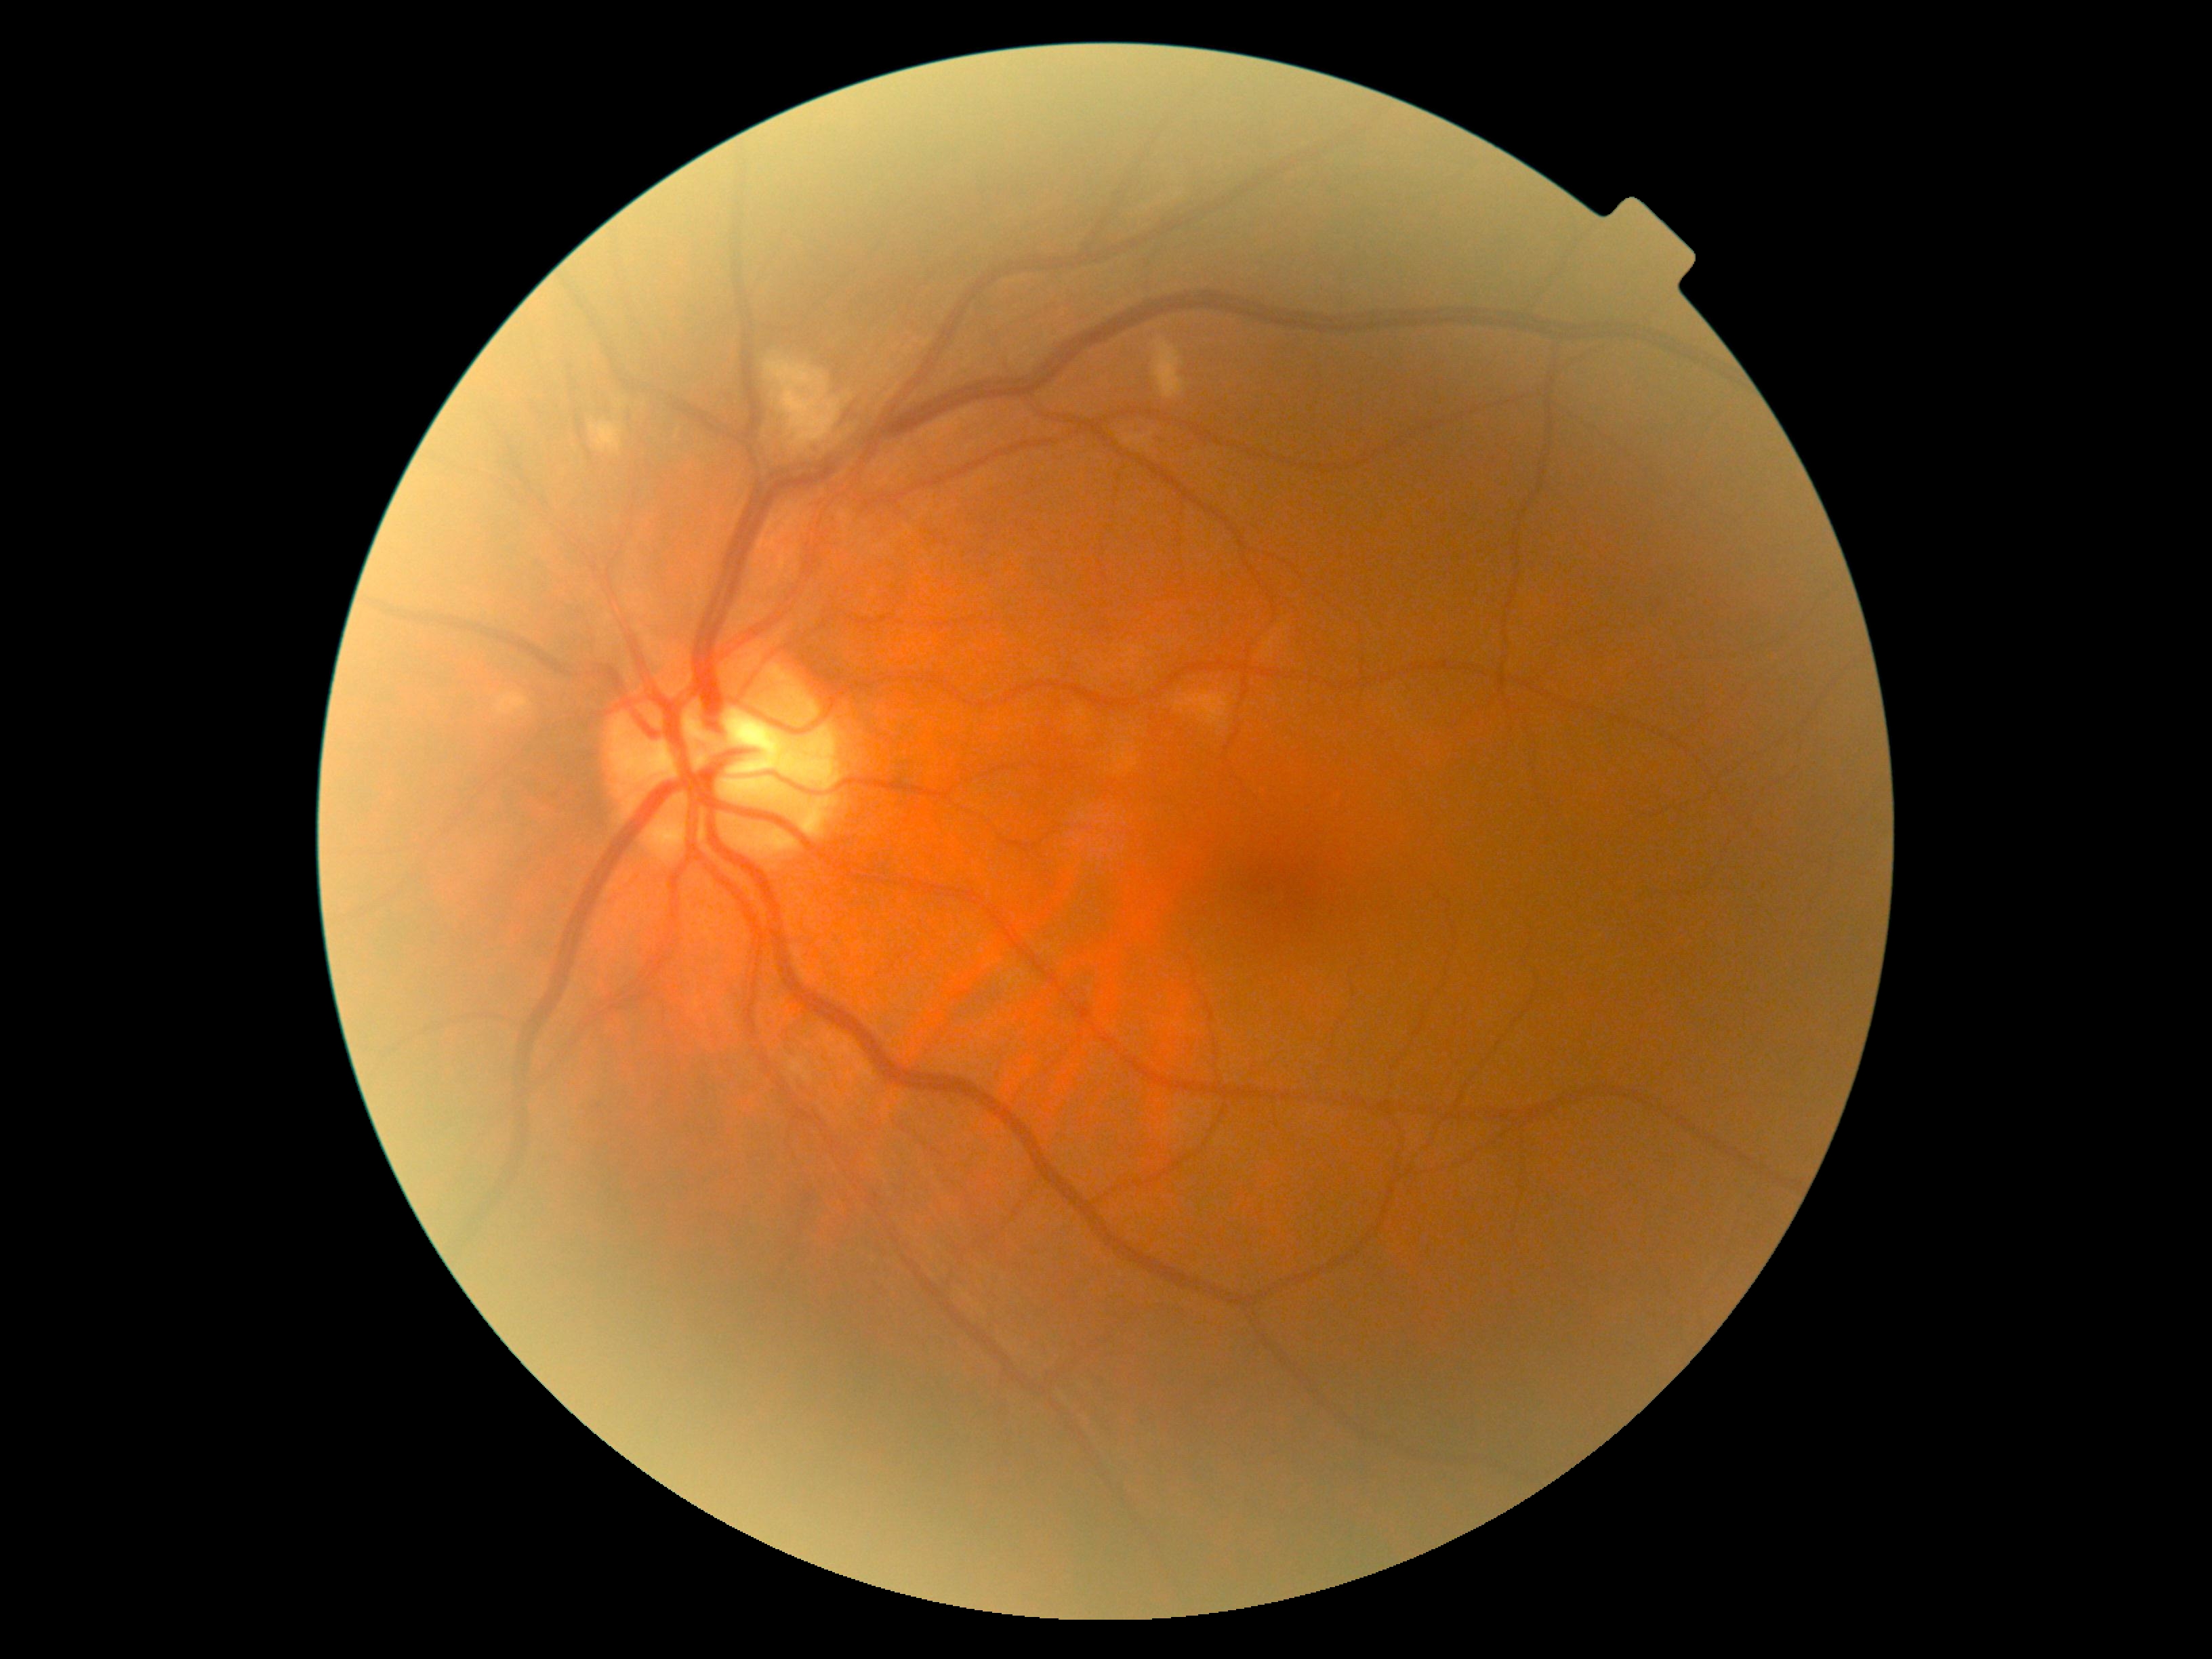
The retinopathy is classified as non-proliferative diabetic retinopathy.
Diabetic retinopathy is grade 2.